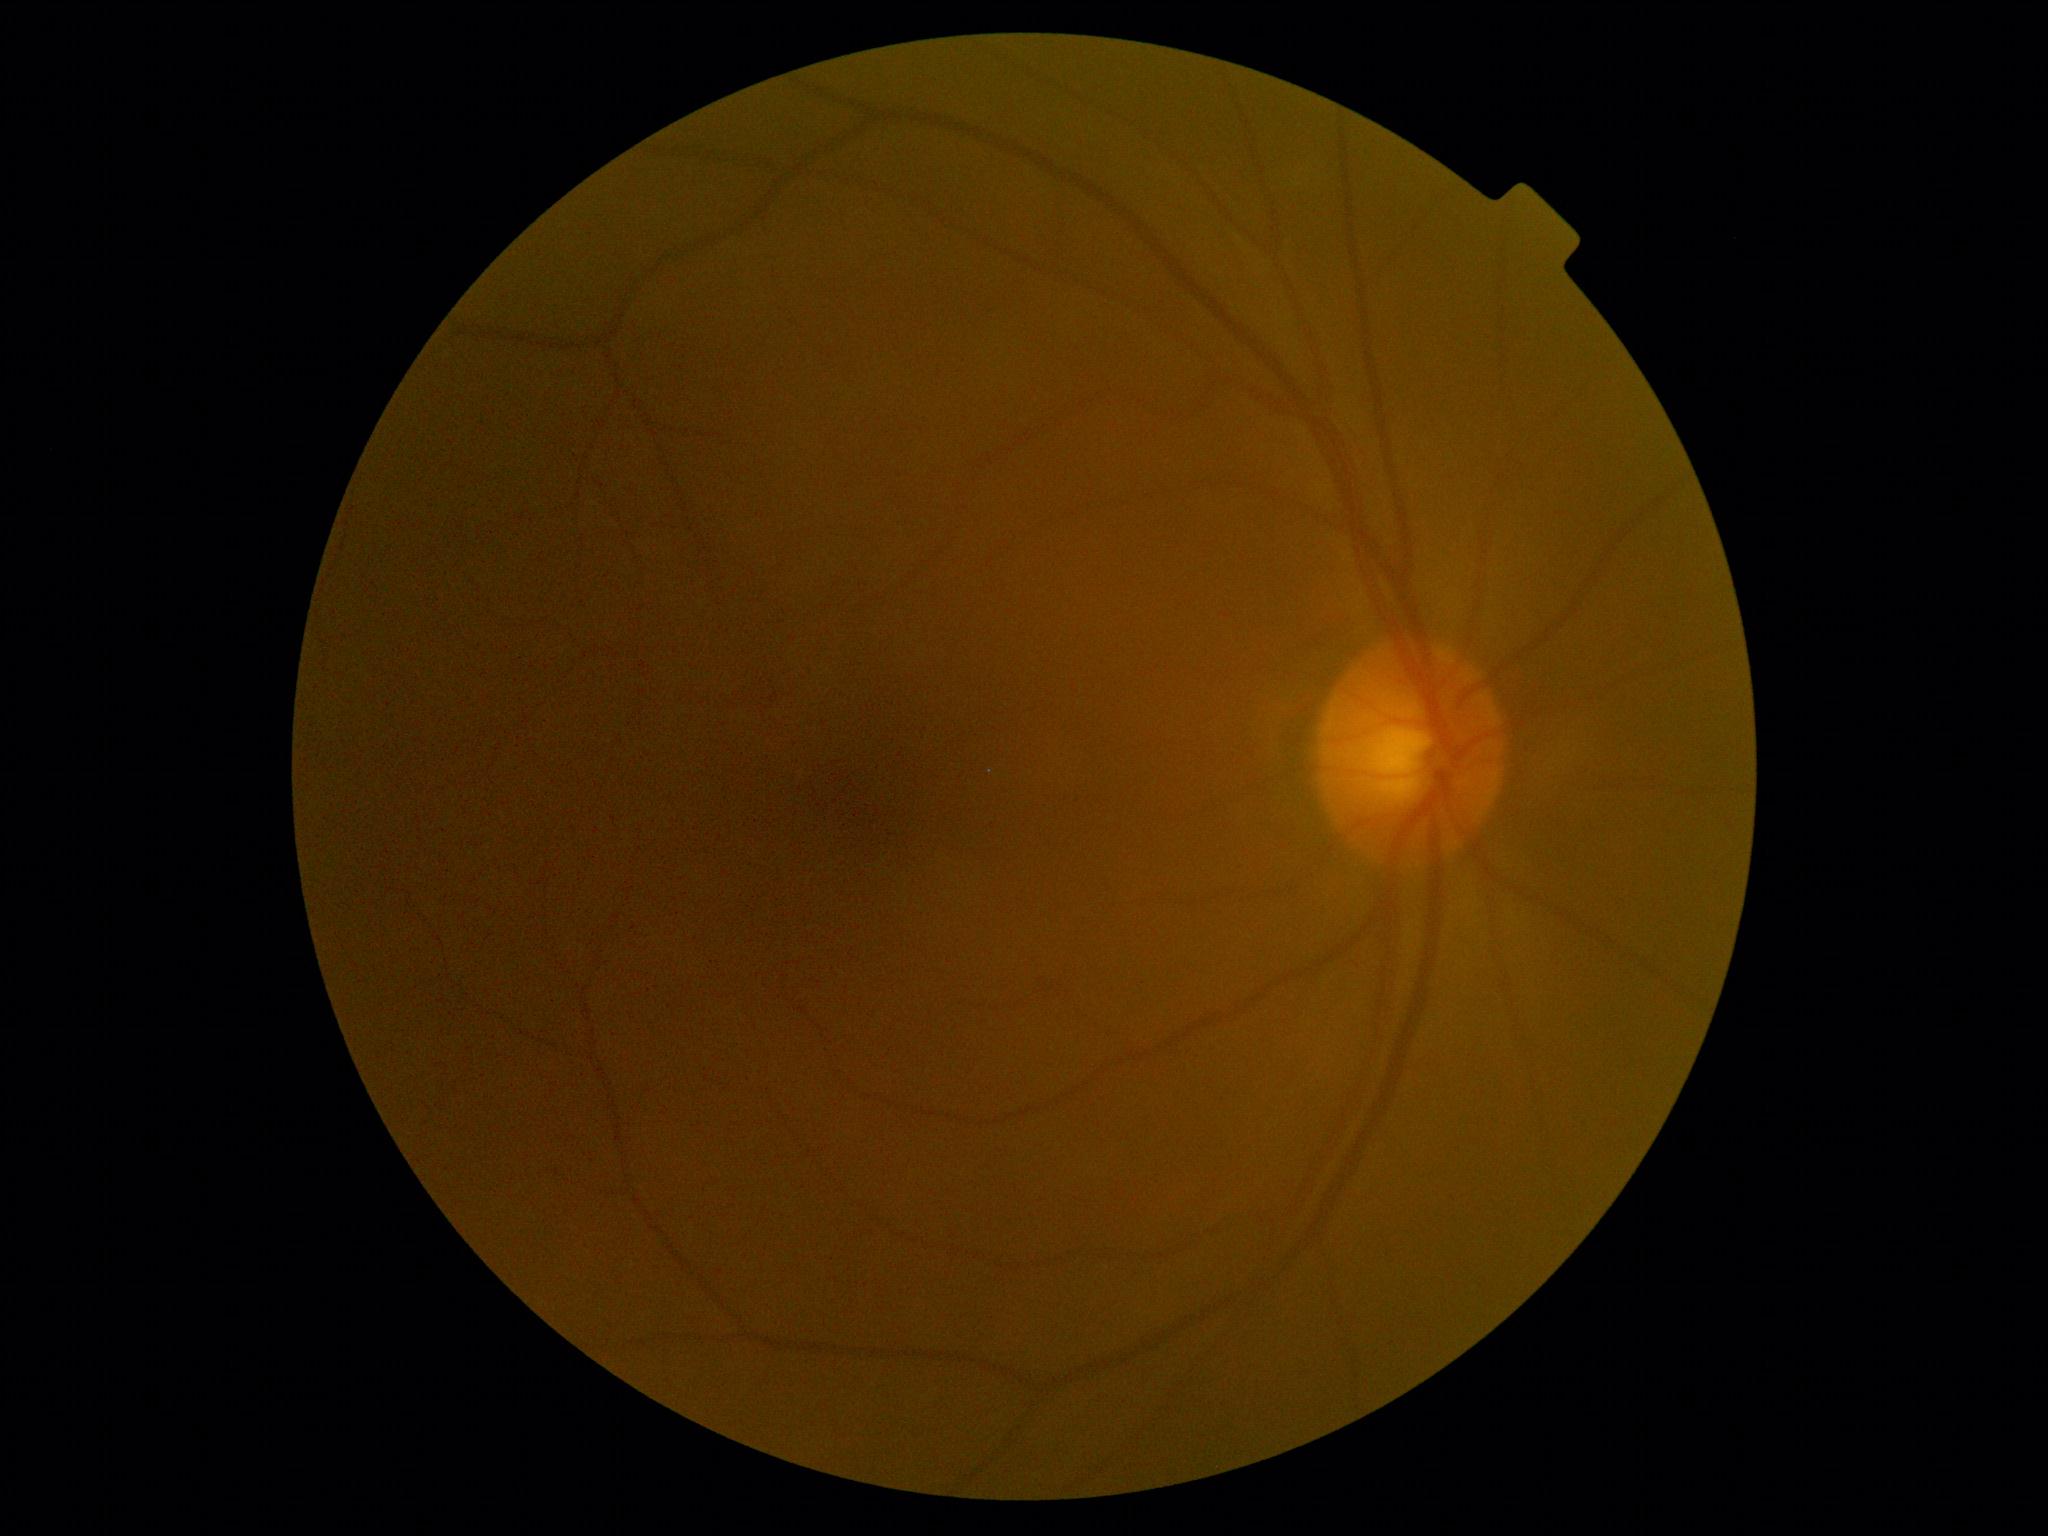

Diabetic retinopathy grade is no apparent diabetic retinopathy (0). No DR findings.